Retinal fundus photograph:
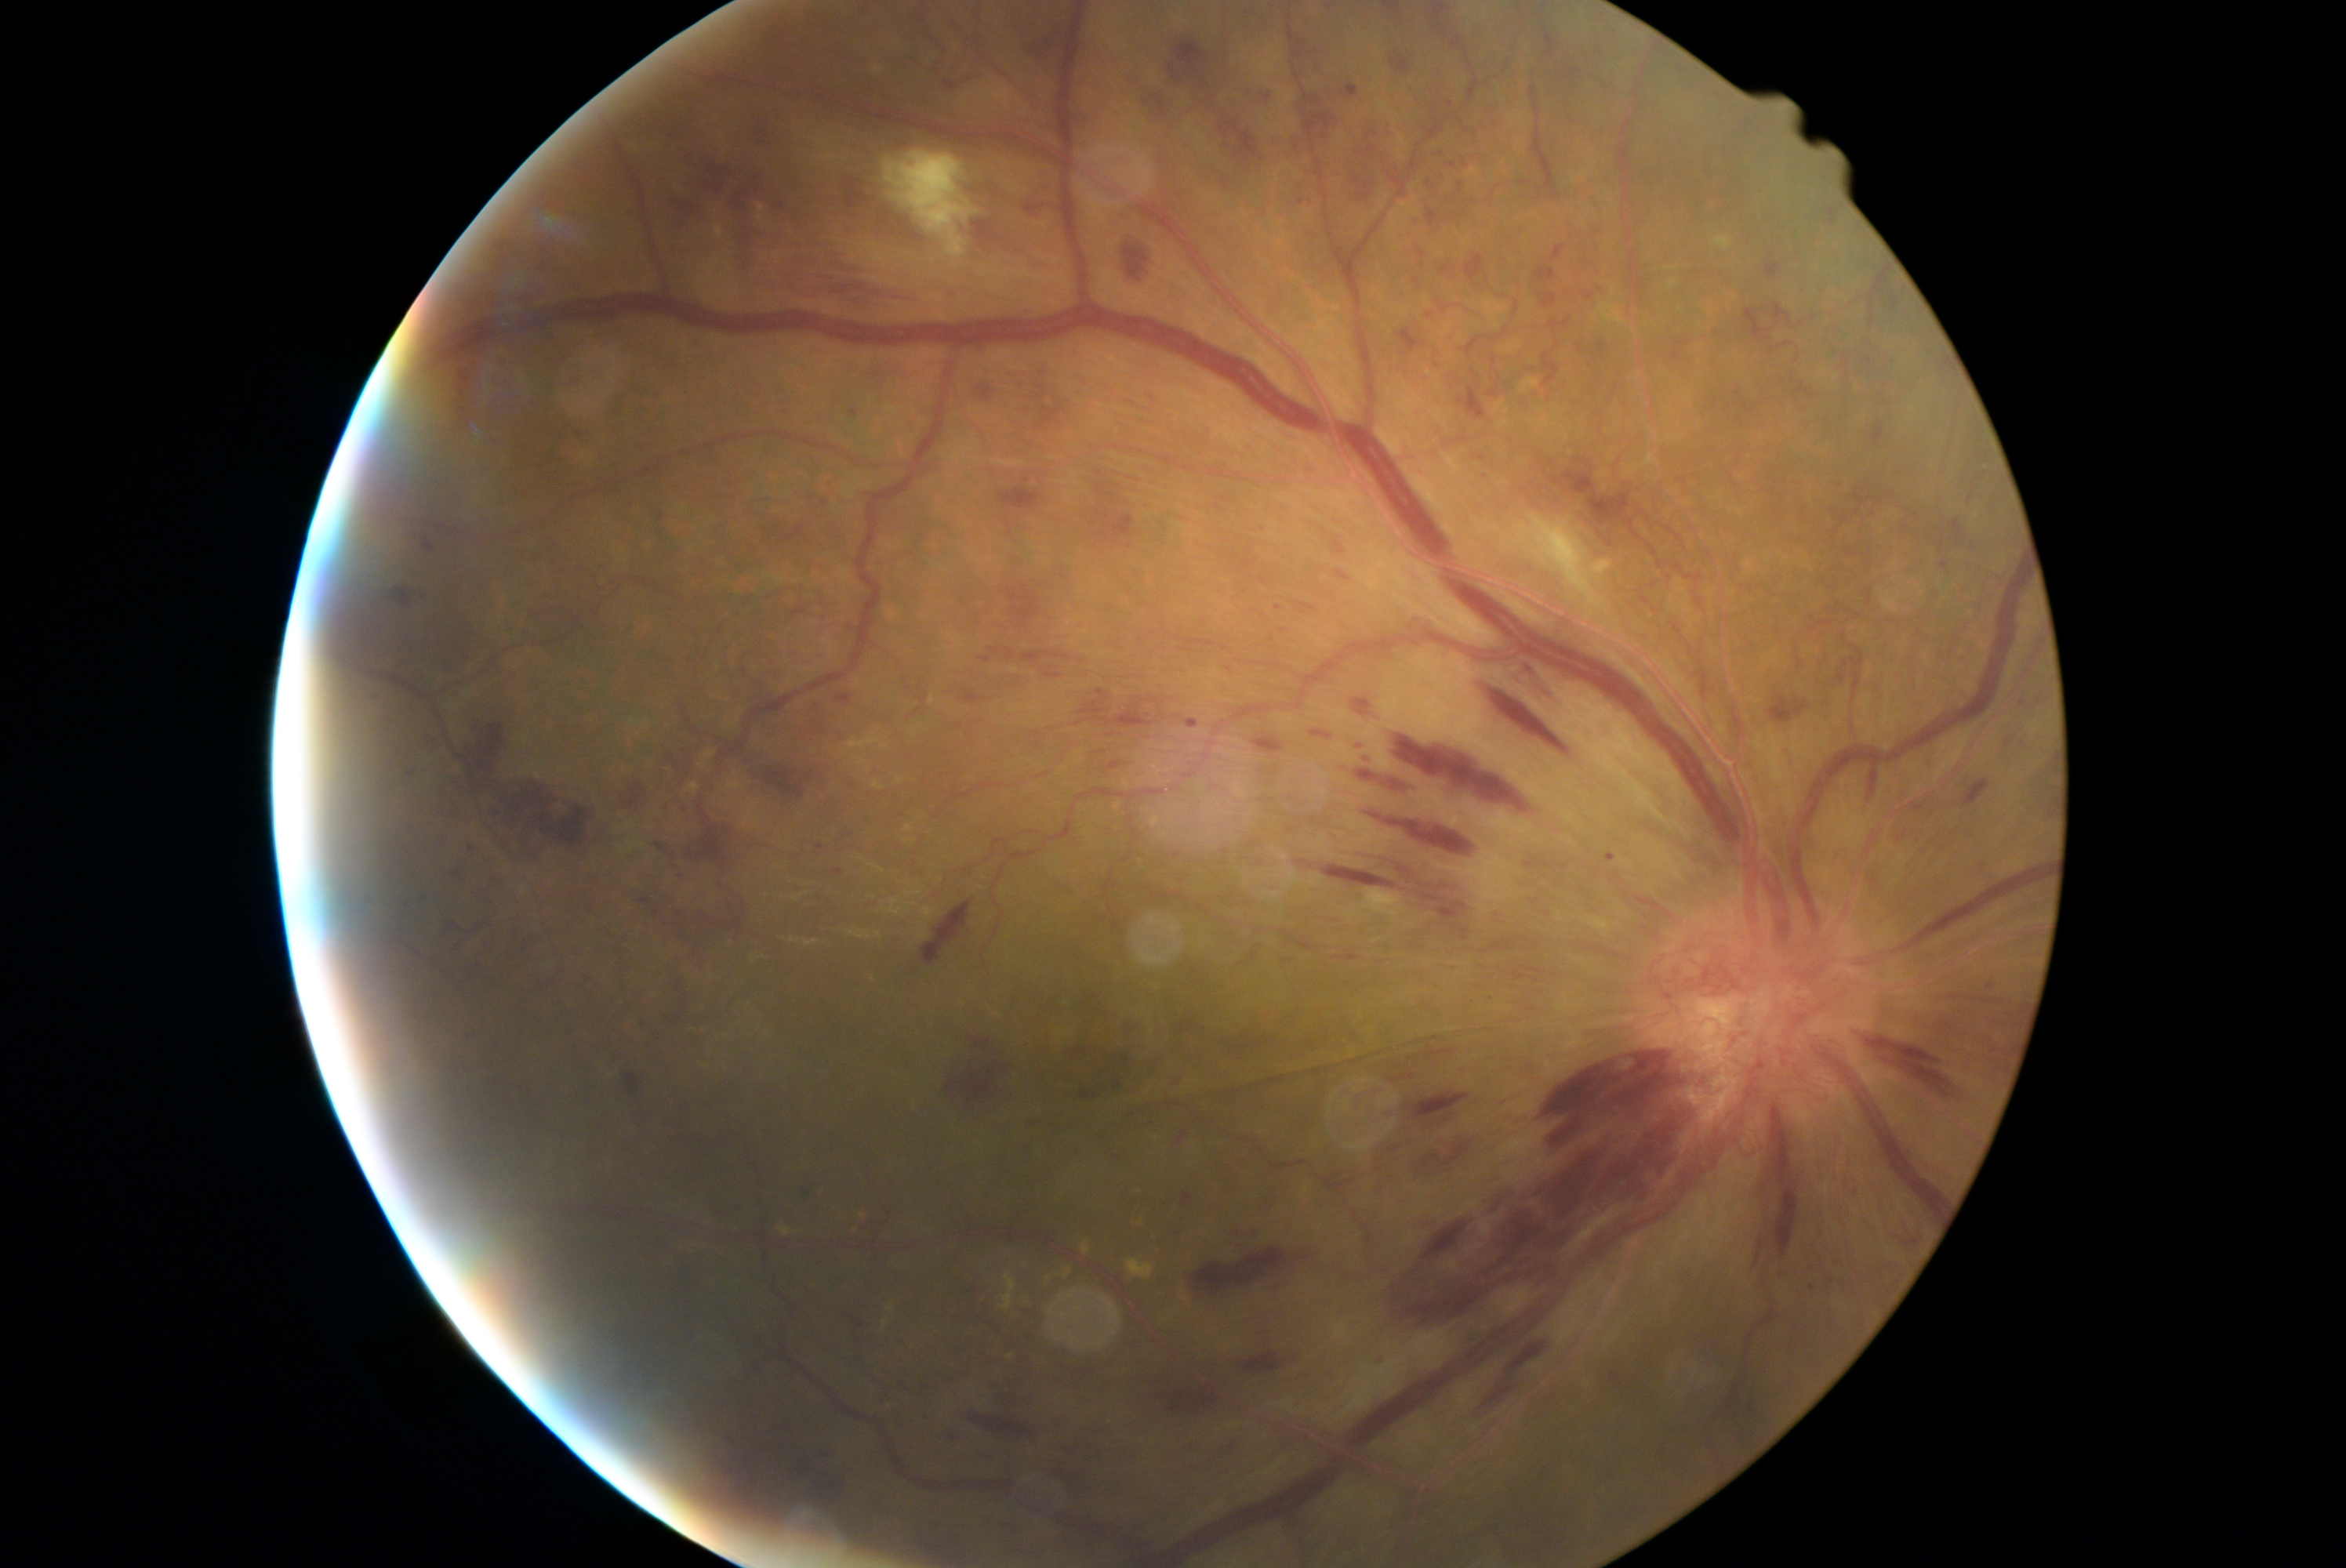

Diabetic retinopathy (DR): grade 4 (PDR); proliferative diabetic retinopathy. Hemorrhages (HEs) (partial list) at l=655, t=843, r=667, b=852, l=1867, t=1037, r=1953, b=1097, l=1872, t=424, r=1886, b=445, l=1961, t=780, r=1989, b=808, l=772, t=239, r=915, b=303, l=1390, t=54, r=1412, b=74, l=446, t=779, r=467, b=810, l=1569, t=68, r=1583, b=79, l=1219, t=118, r=1263, b=164, l=697, t=822, r=727, b=869, l=802, t=1177, r=812, b=1202, l=976, t=639, r=1081, b=669, l=1605, t=854, r=1616, b=862, l=1331, t=568, r=1356, b=583, l=1771, t=695, r=1809, b=724, l=1450, t=164, r=1459, b=170, l=1756, t=1240, r=1763, b=1263. Additional small HEs near (2022,702), (1589,297), (1205,1030).